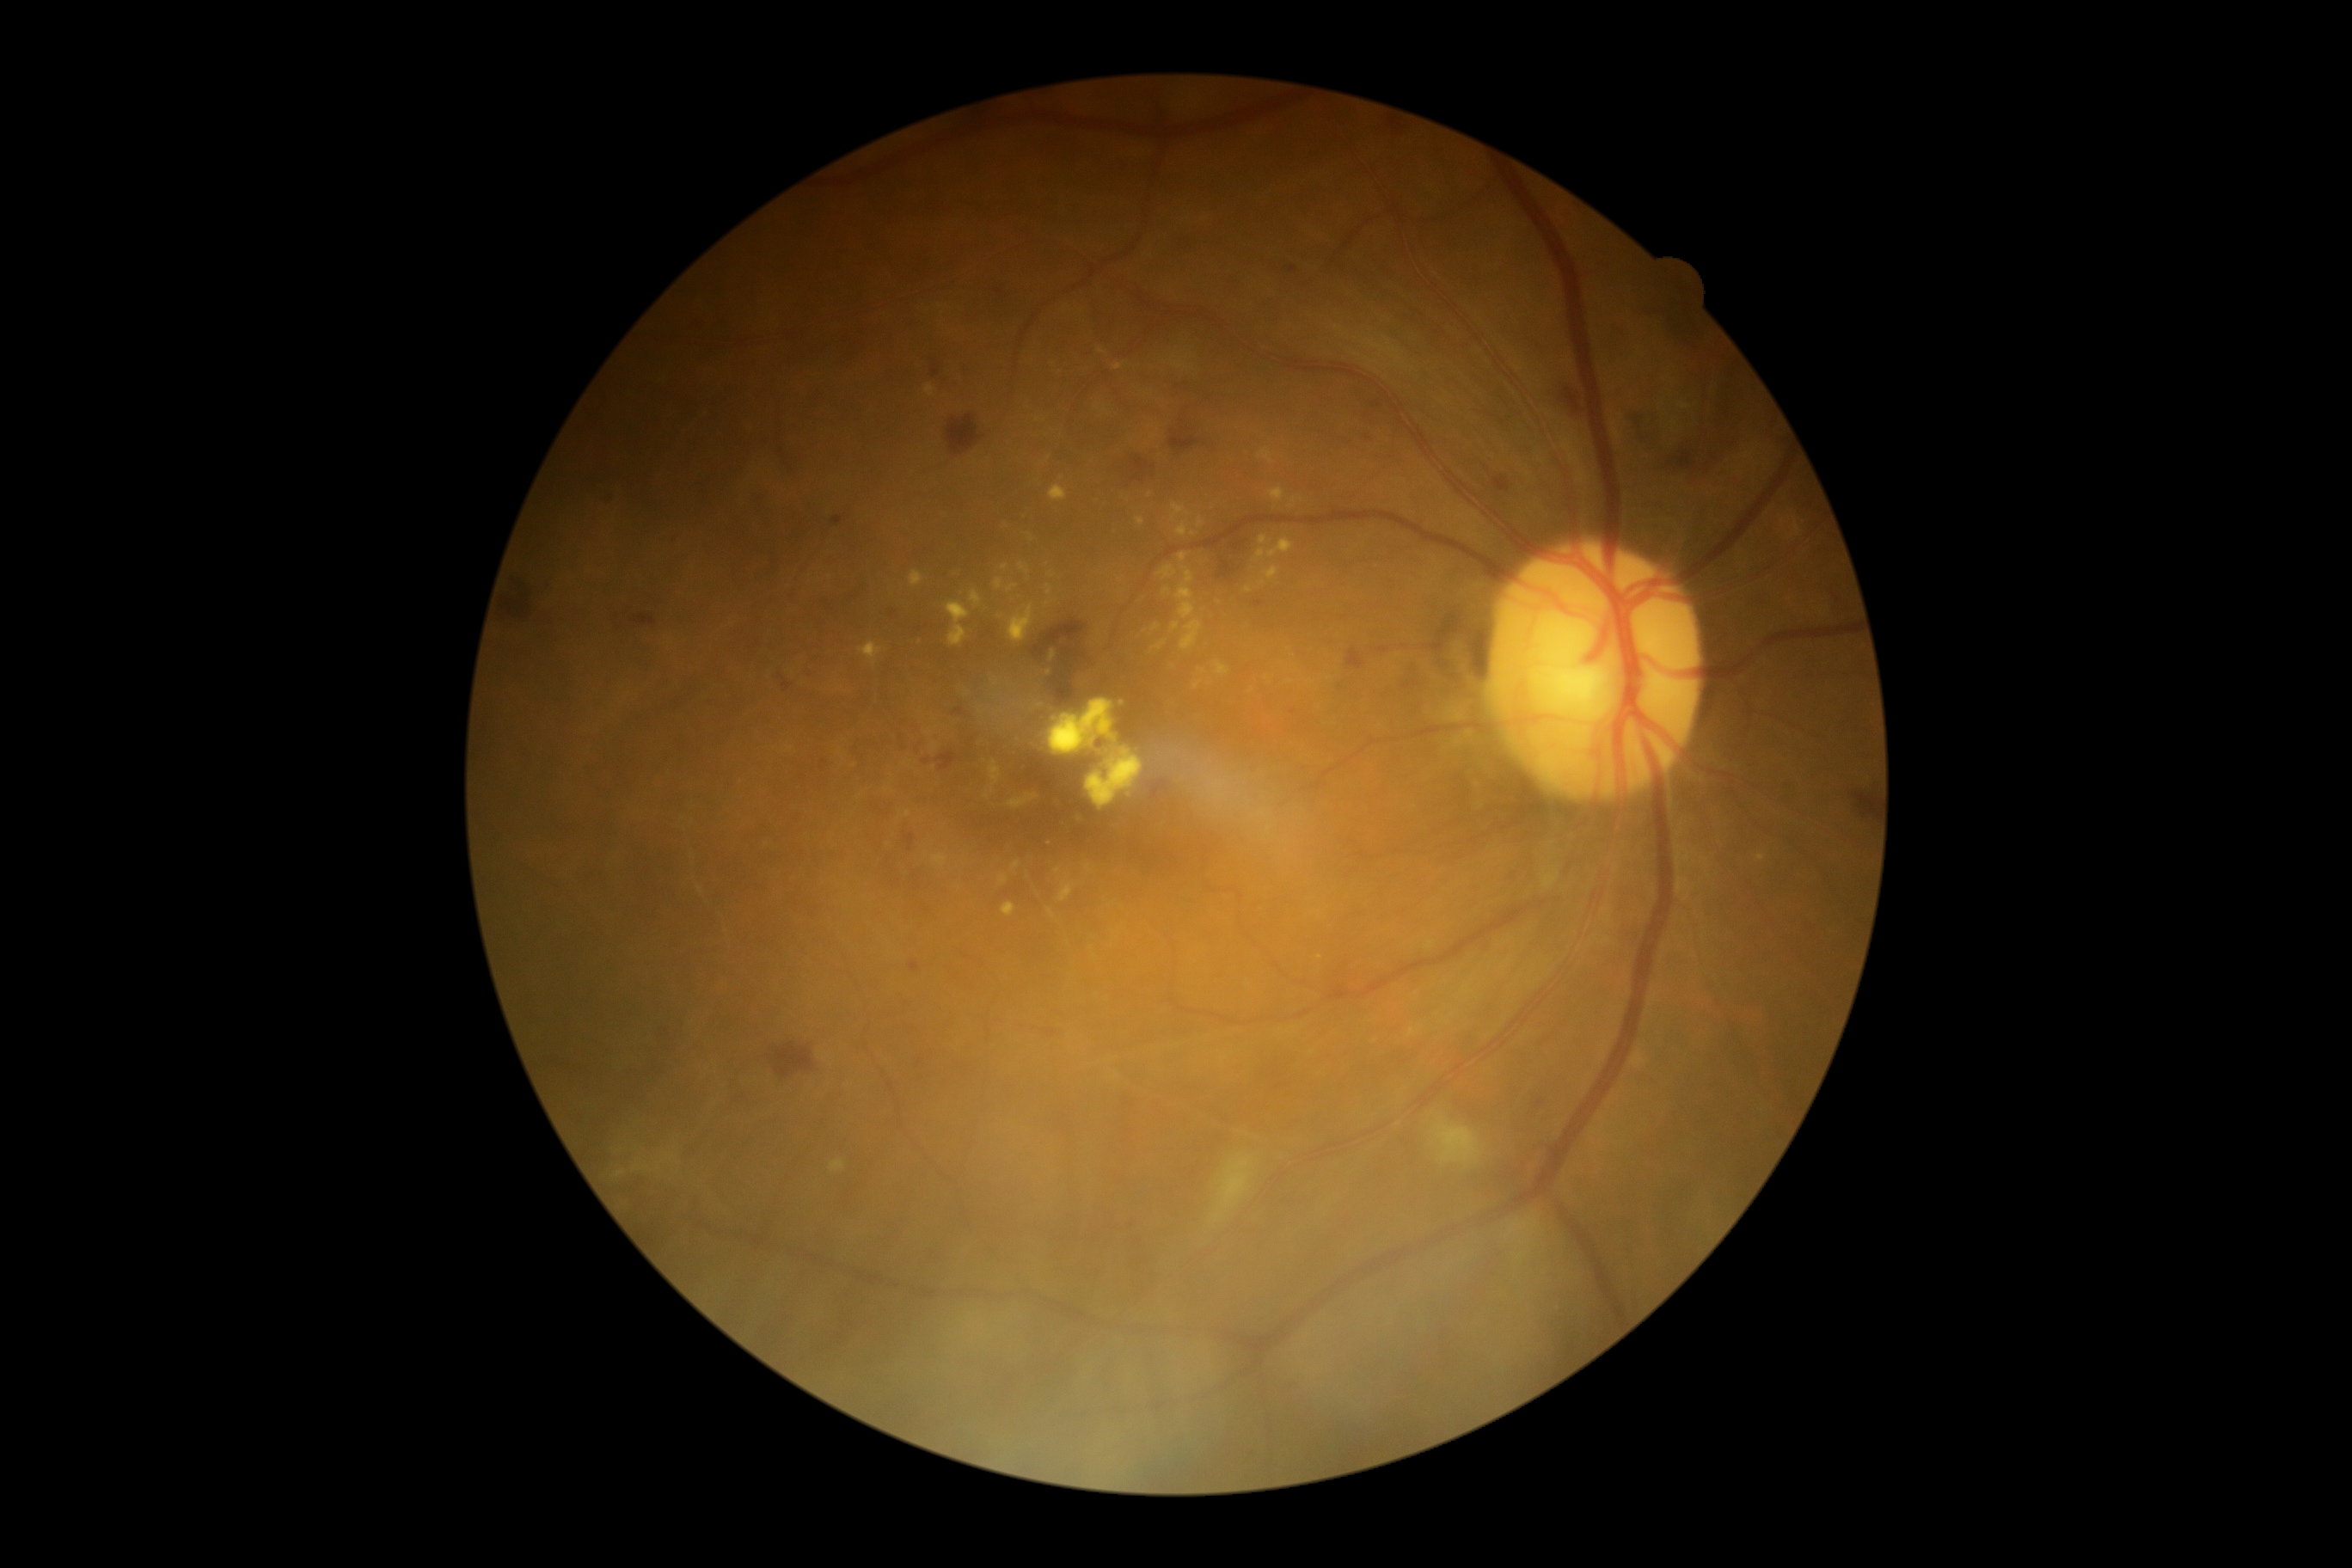
DR class: non-proliferative diabetic retinopathy. Diabetic retinopathy (DR) is grade 2.